2352x1568: 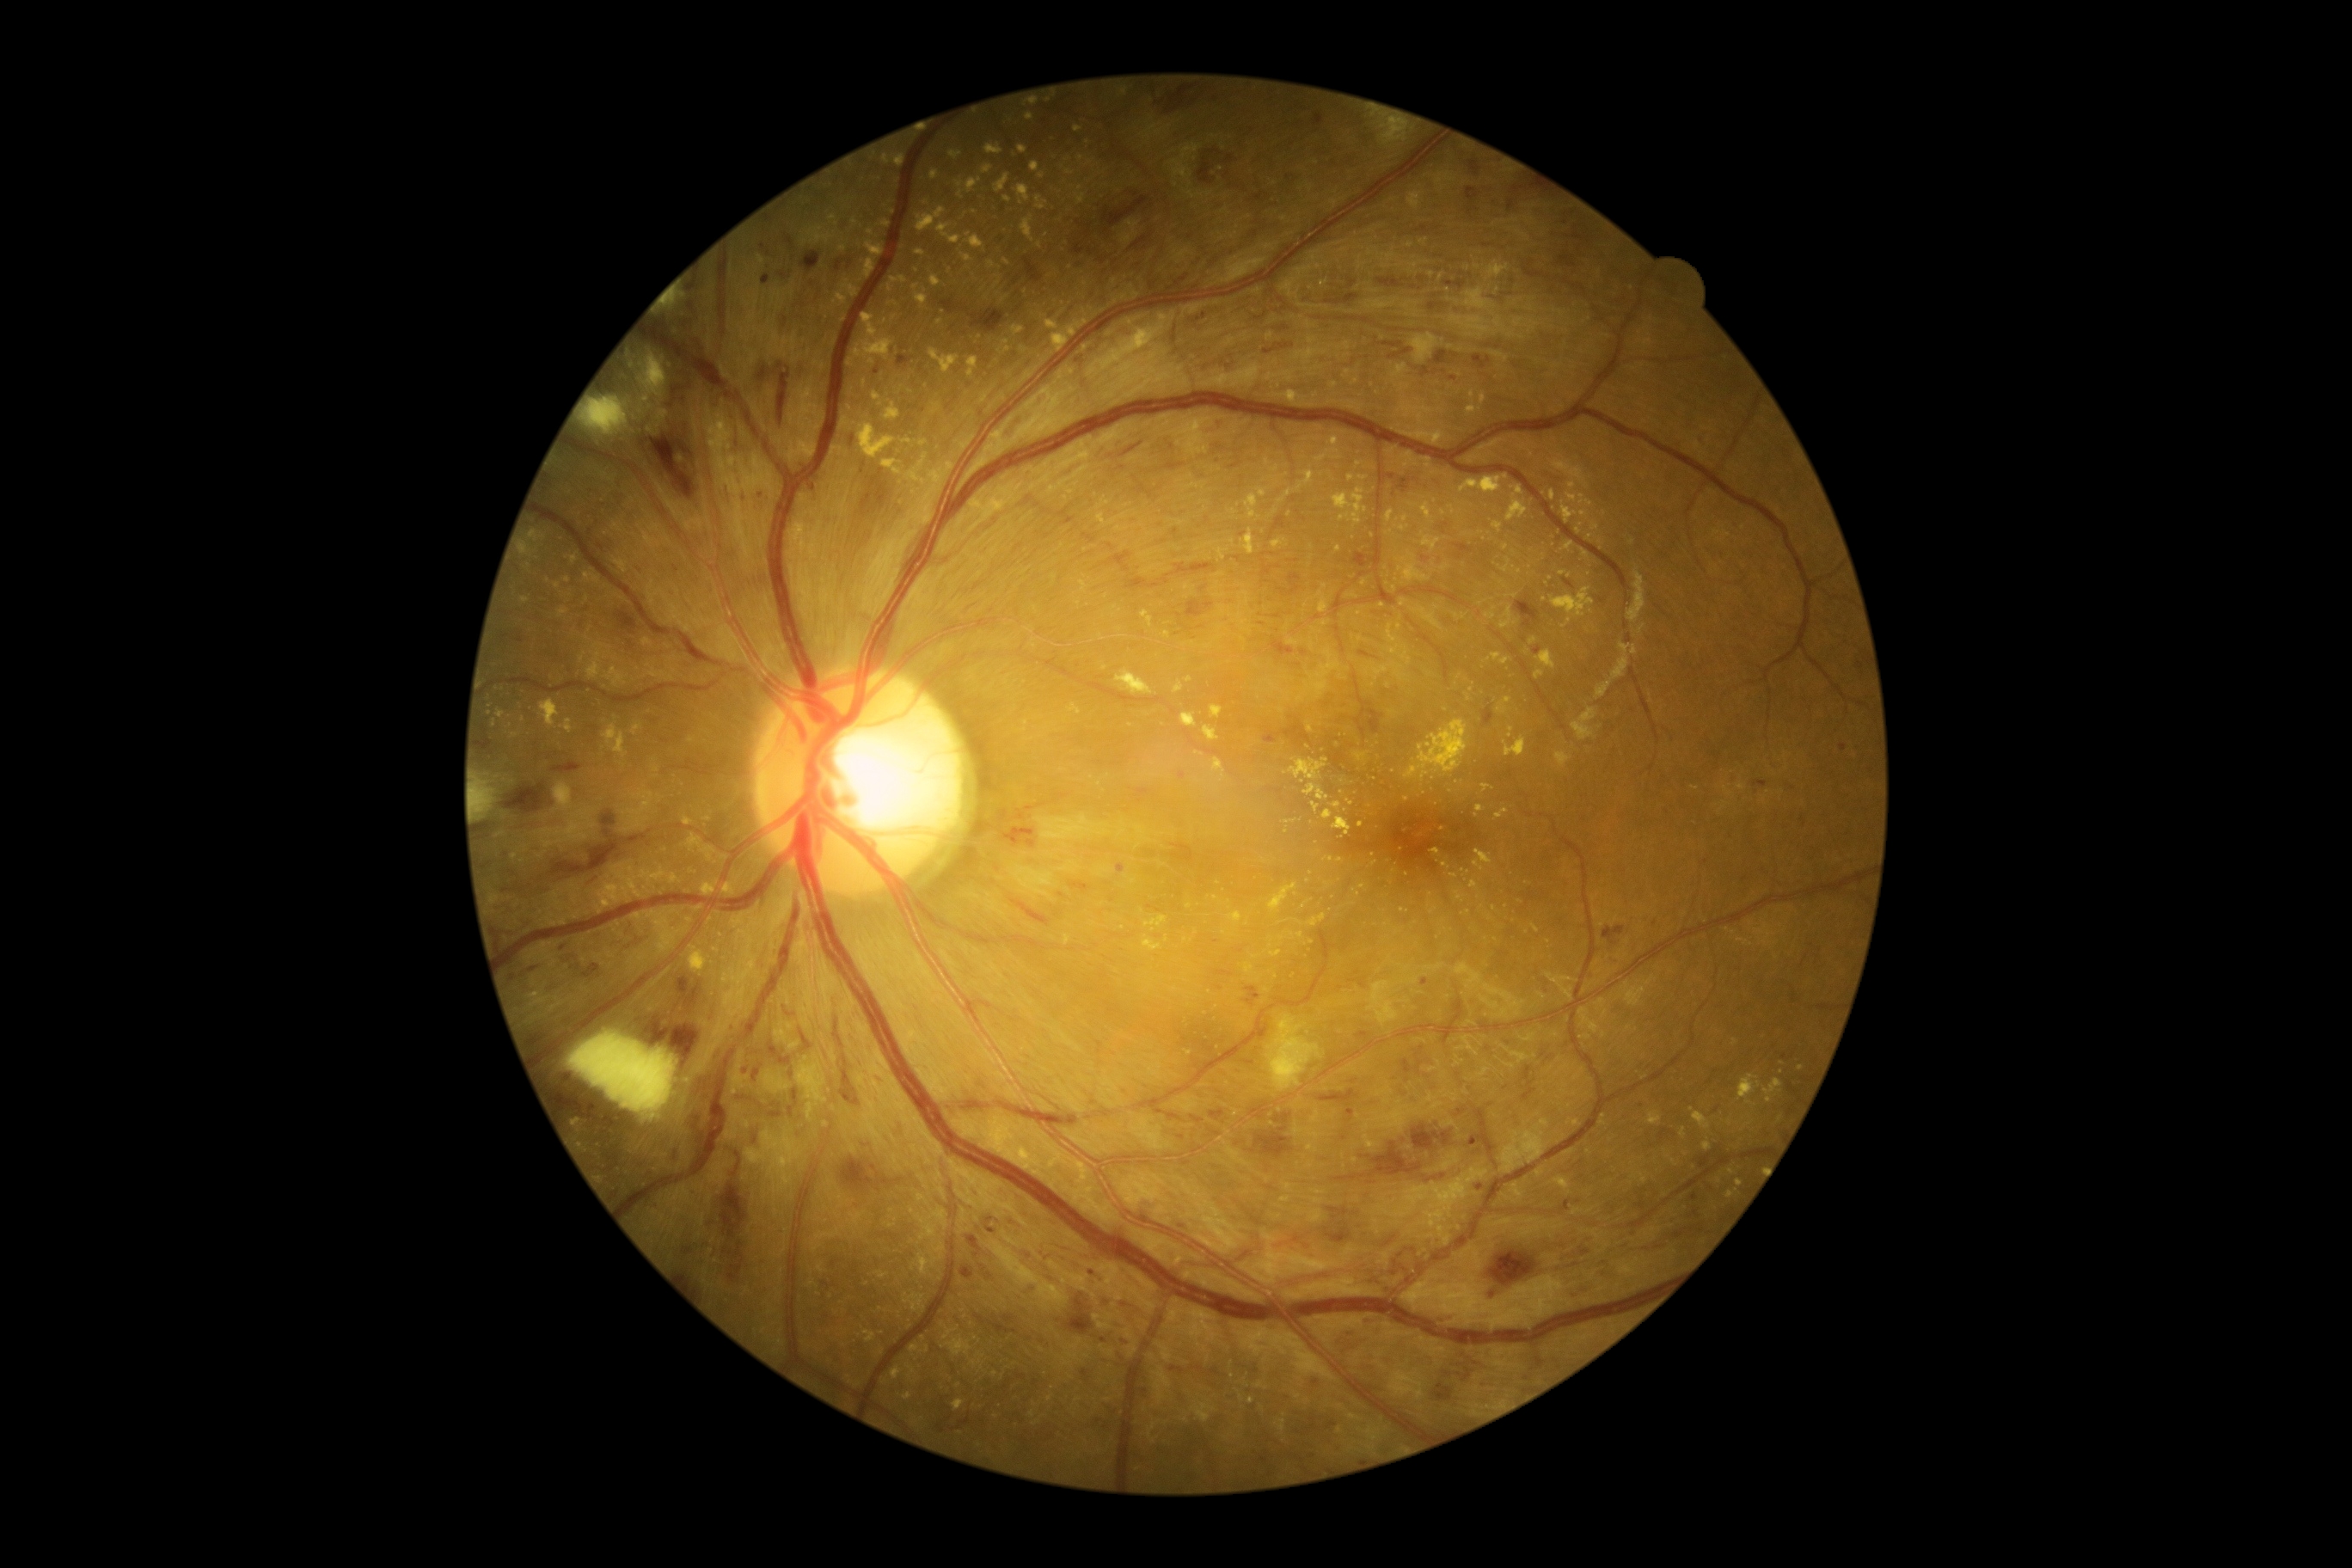

Findings:
• DR class — non-proliferative diabetic retinopathy
• DR severity — severe NPDR (grade 3)